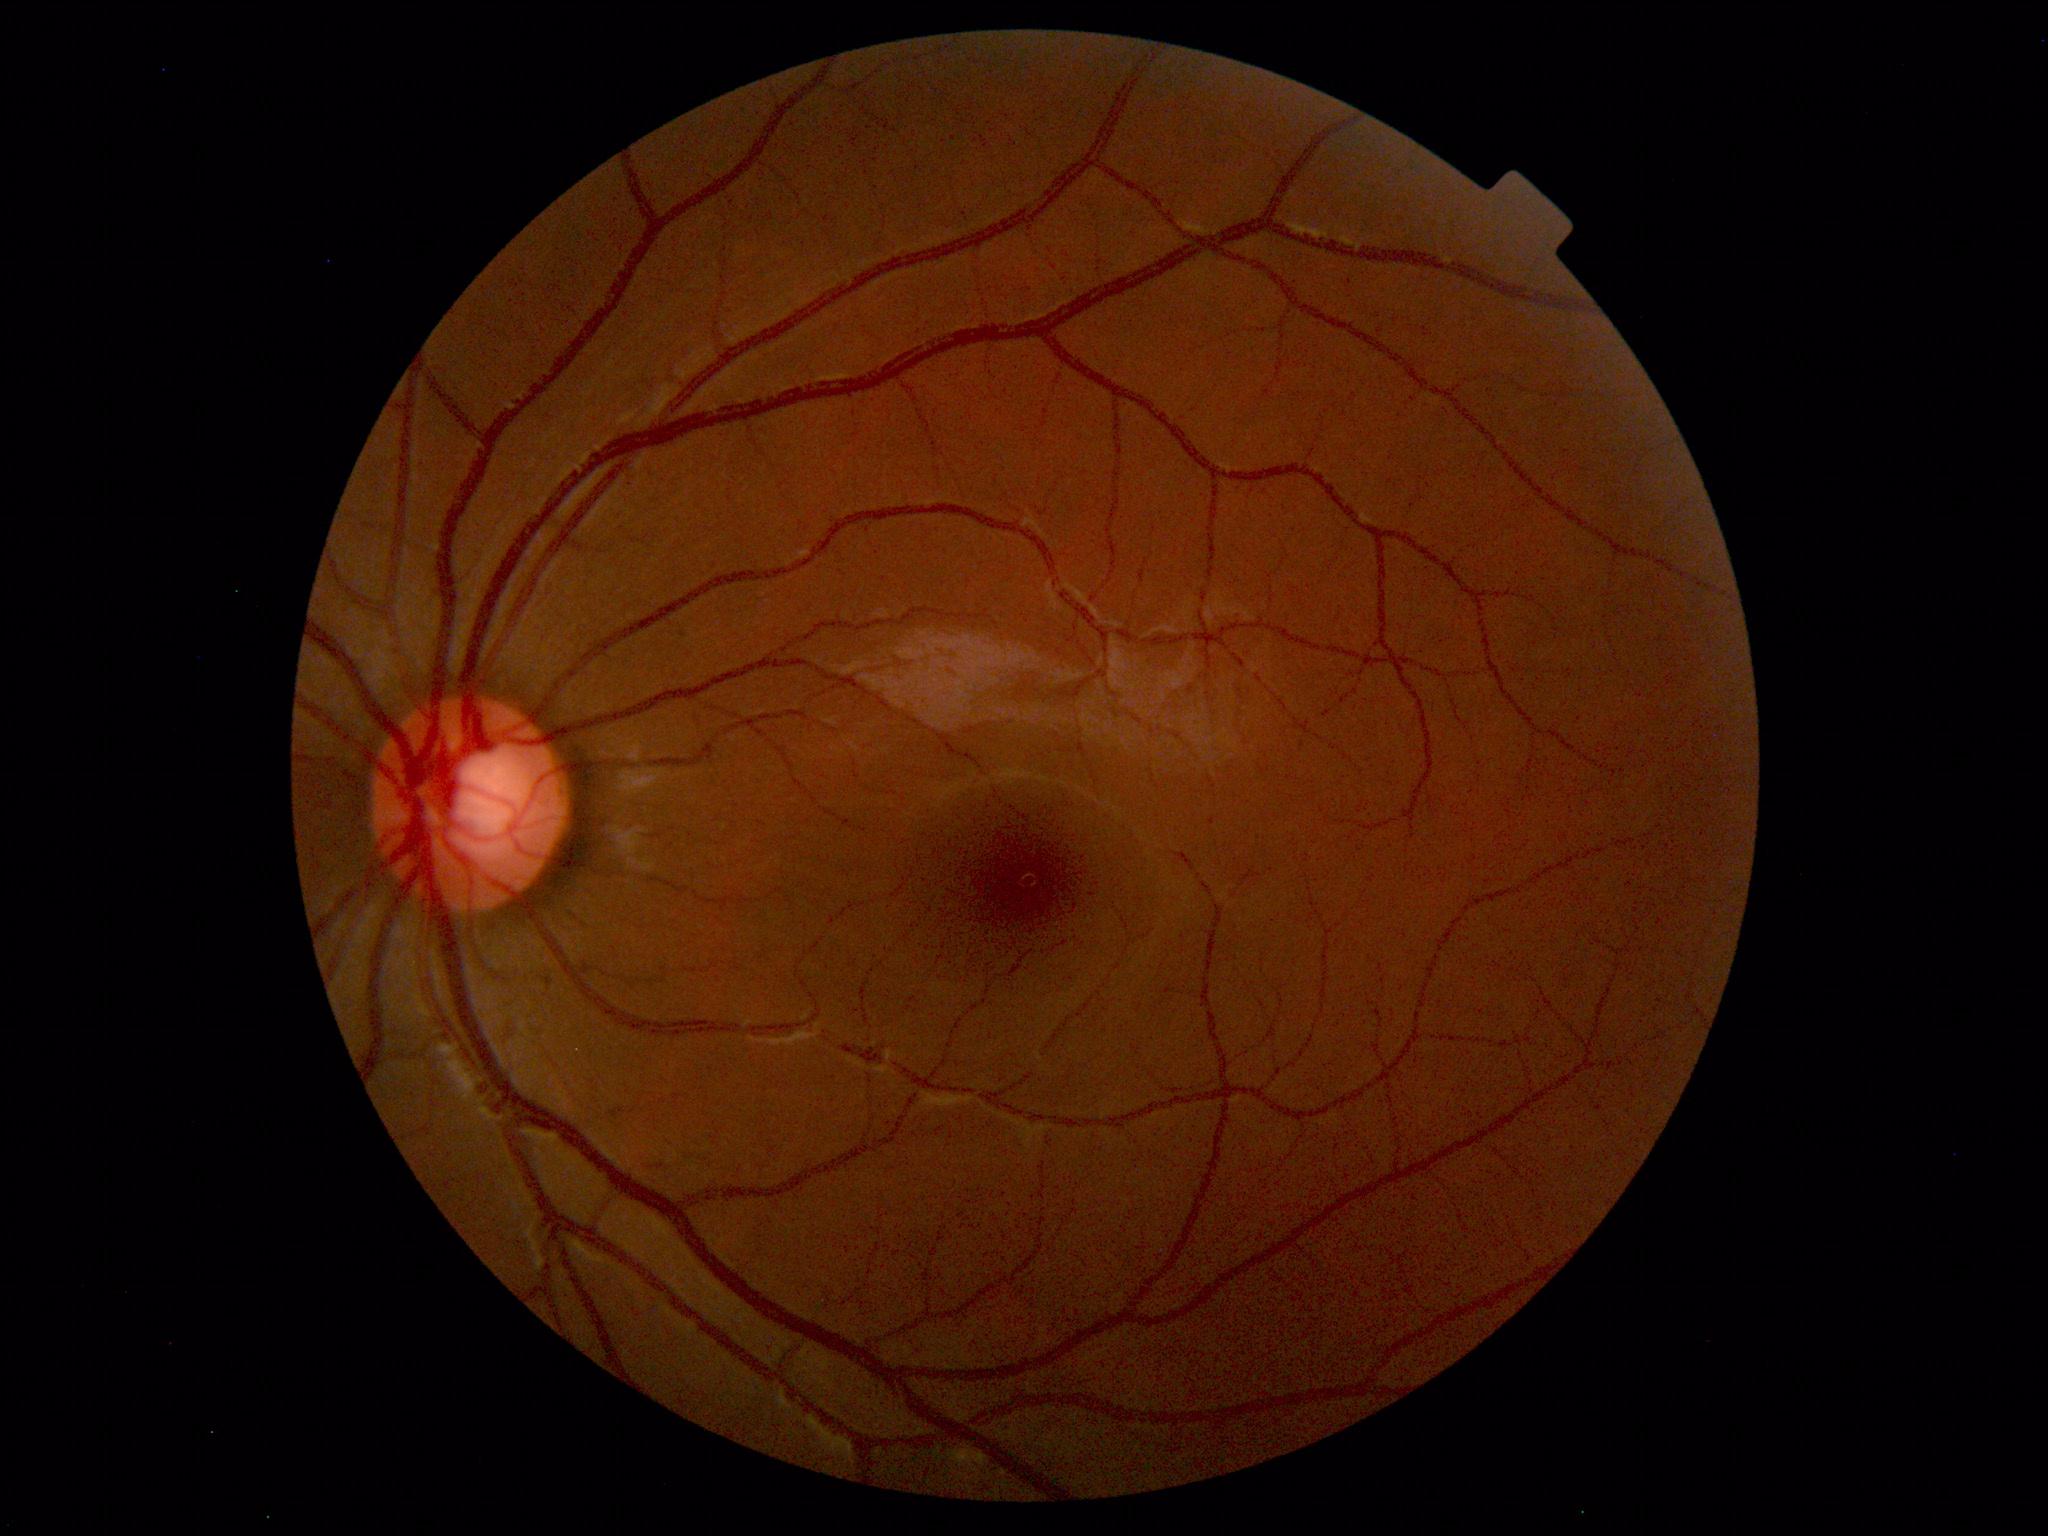
Impression: within normal limits.